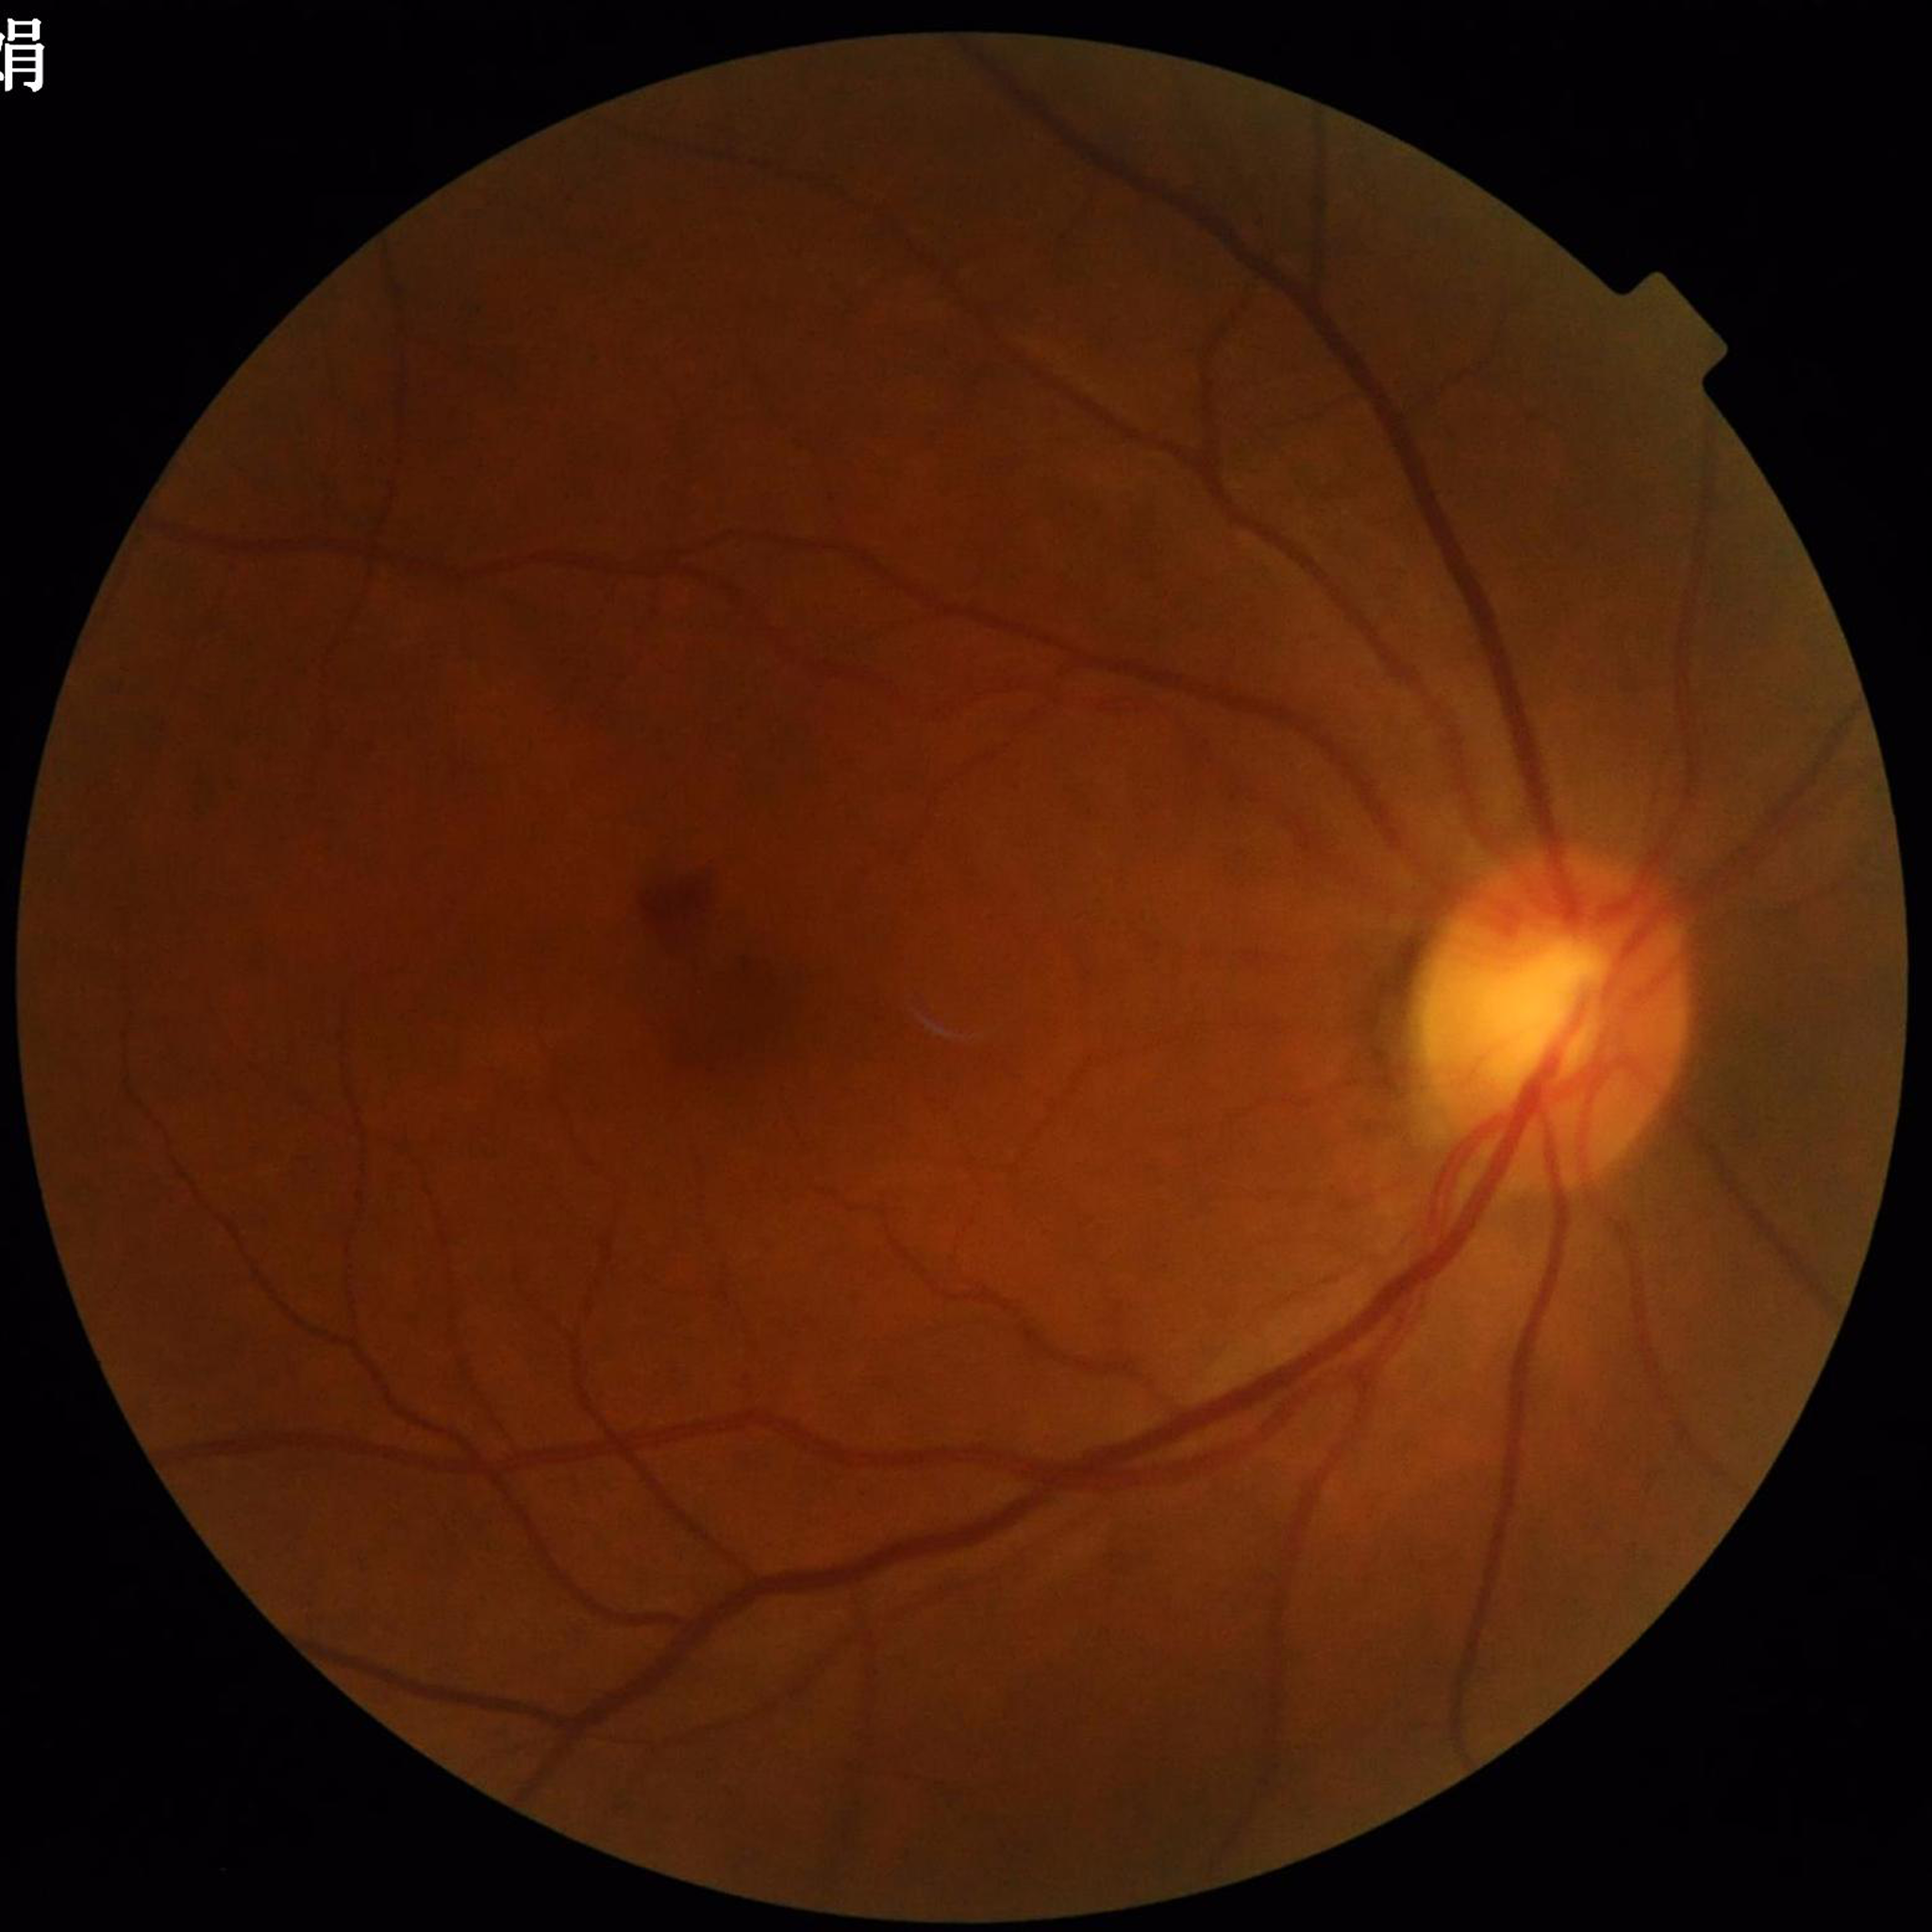 Diagnosed with DR.